Fundus photo — 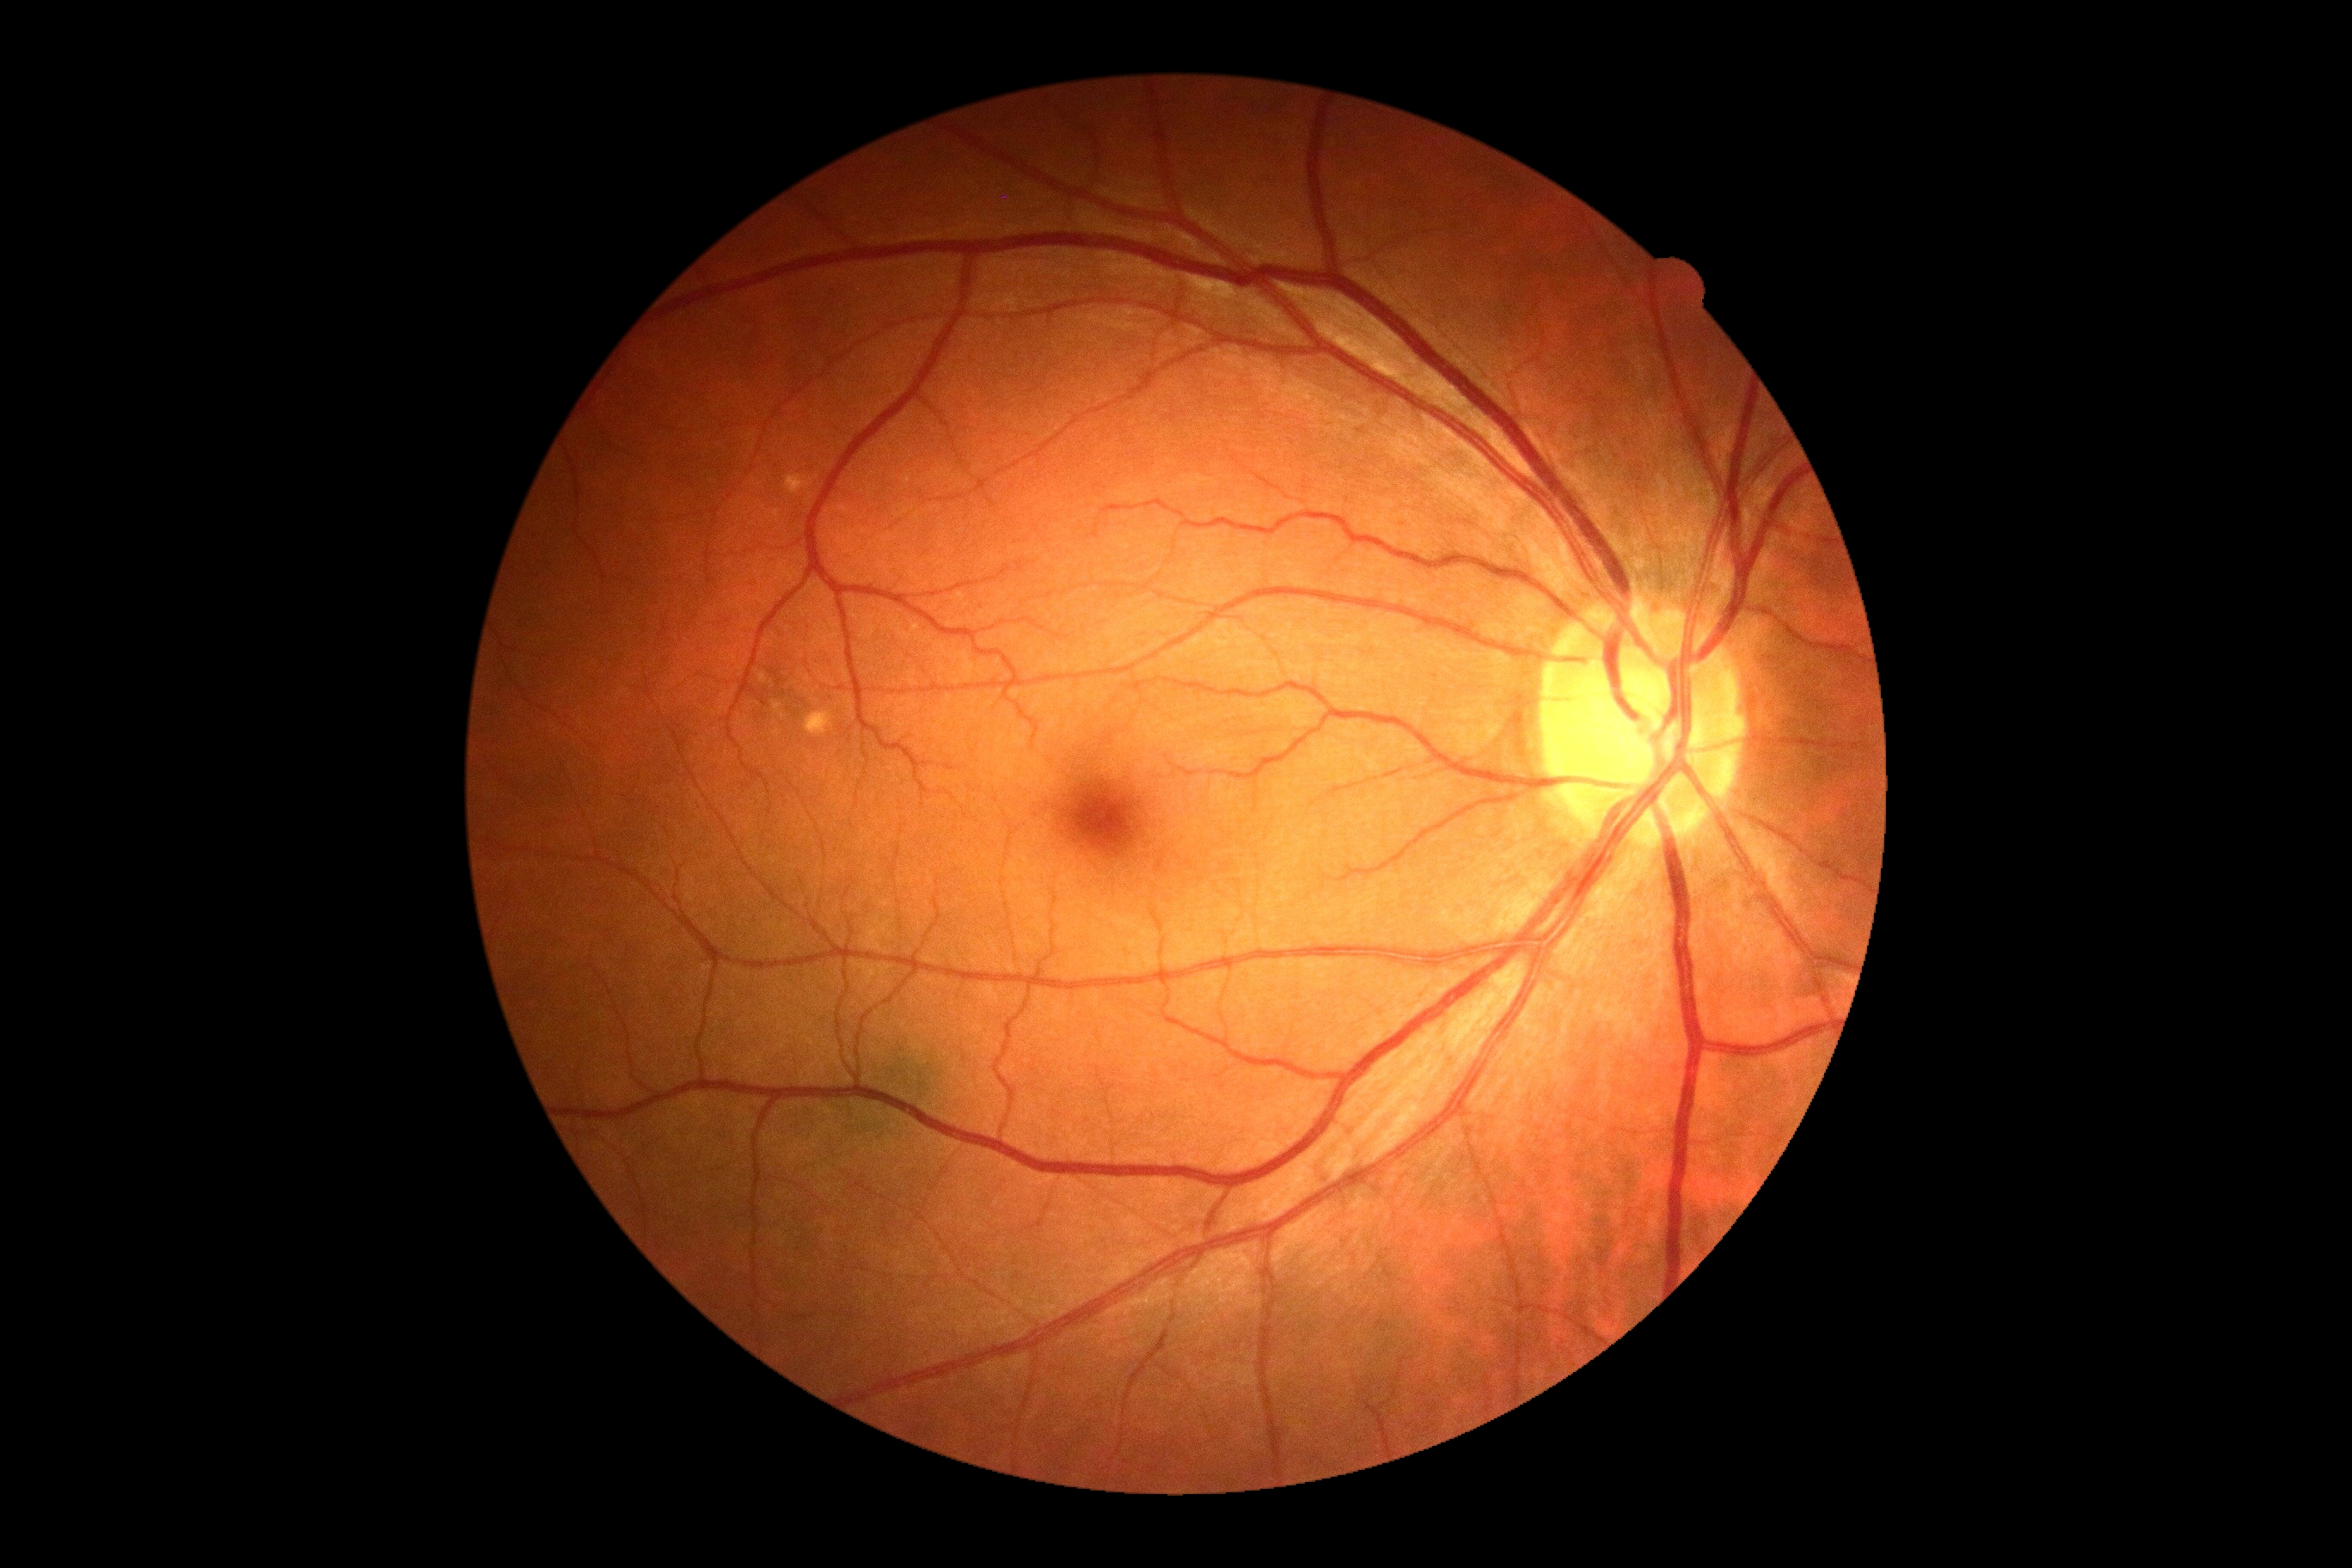
DR is no apparent diabetic retinopathy (grade 0) — no visible signs of diabetic retinopathy. No signs of diabetic retinopathy.